Diabetic retinopathy graded by the modified Davis classification:
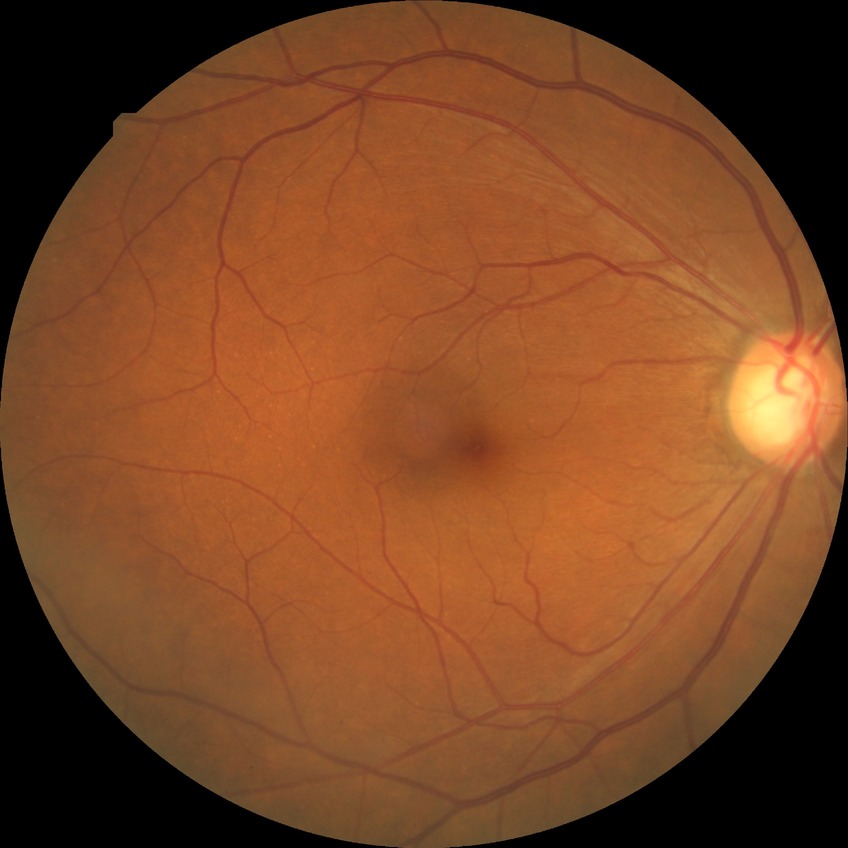
Diabetic retinopathy (DR): no diabetic retinopathy (NDR).